Posterior pole photograph. 45° field of view. 848x848.
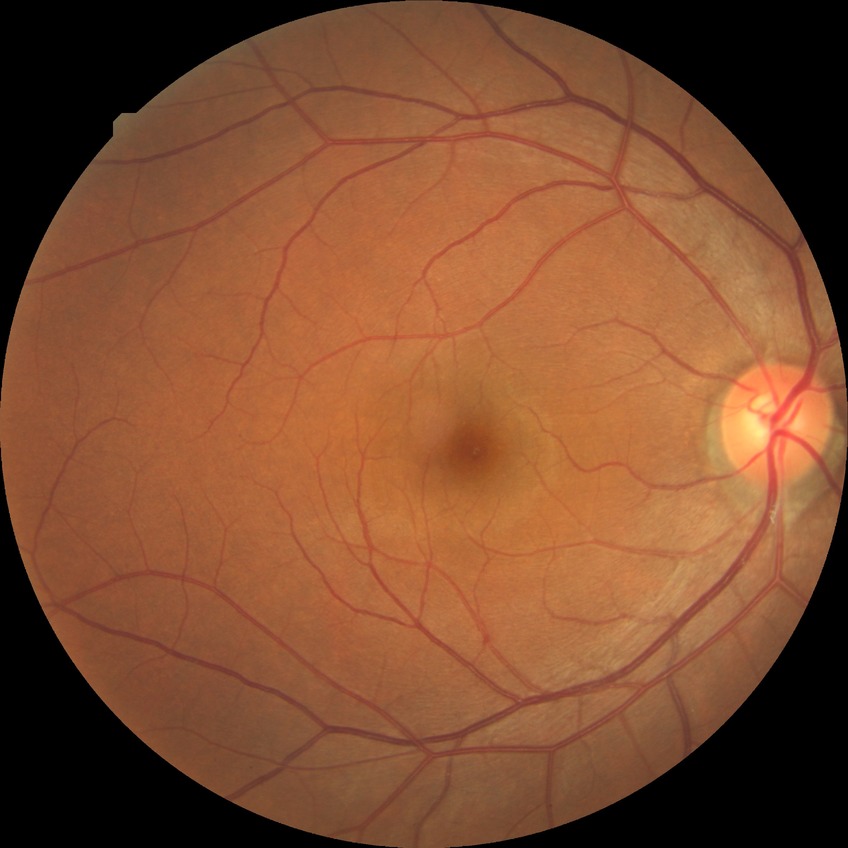
Diabetic retinopathy (DR): NDR (no diabetic retinopathy).